Color fundus image, 1470x1137px:
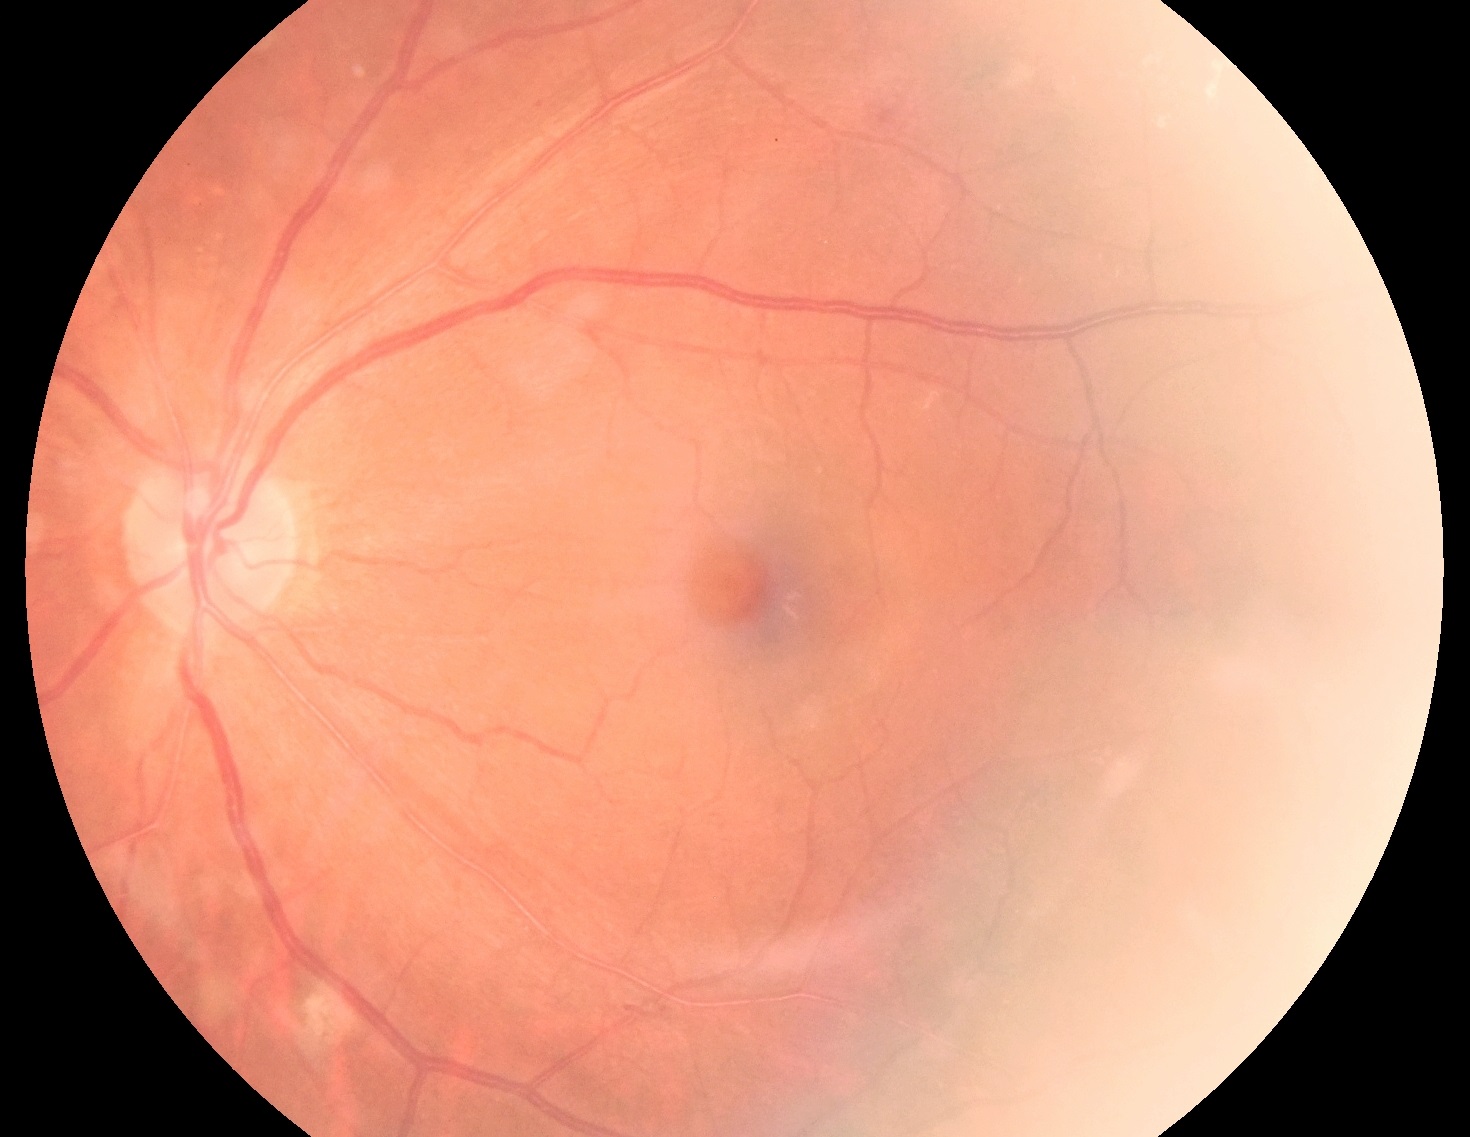
diabetic retinopathy grade@moderate NPDR (2) — more than just microaneurysms but less than severe NPDR; DR class@non-proliferative diabetic retinopathy.